45-degree field of view
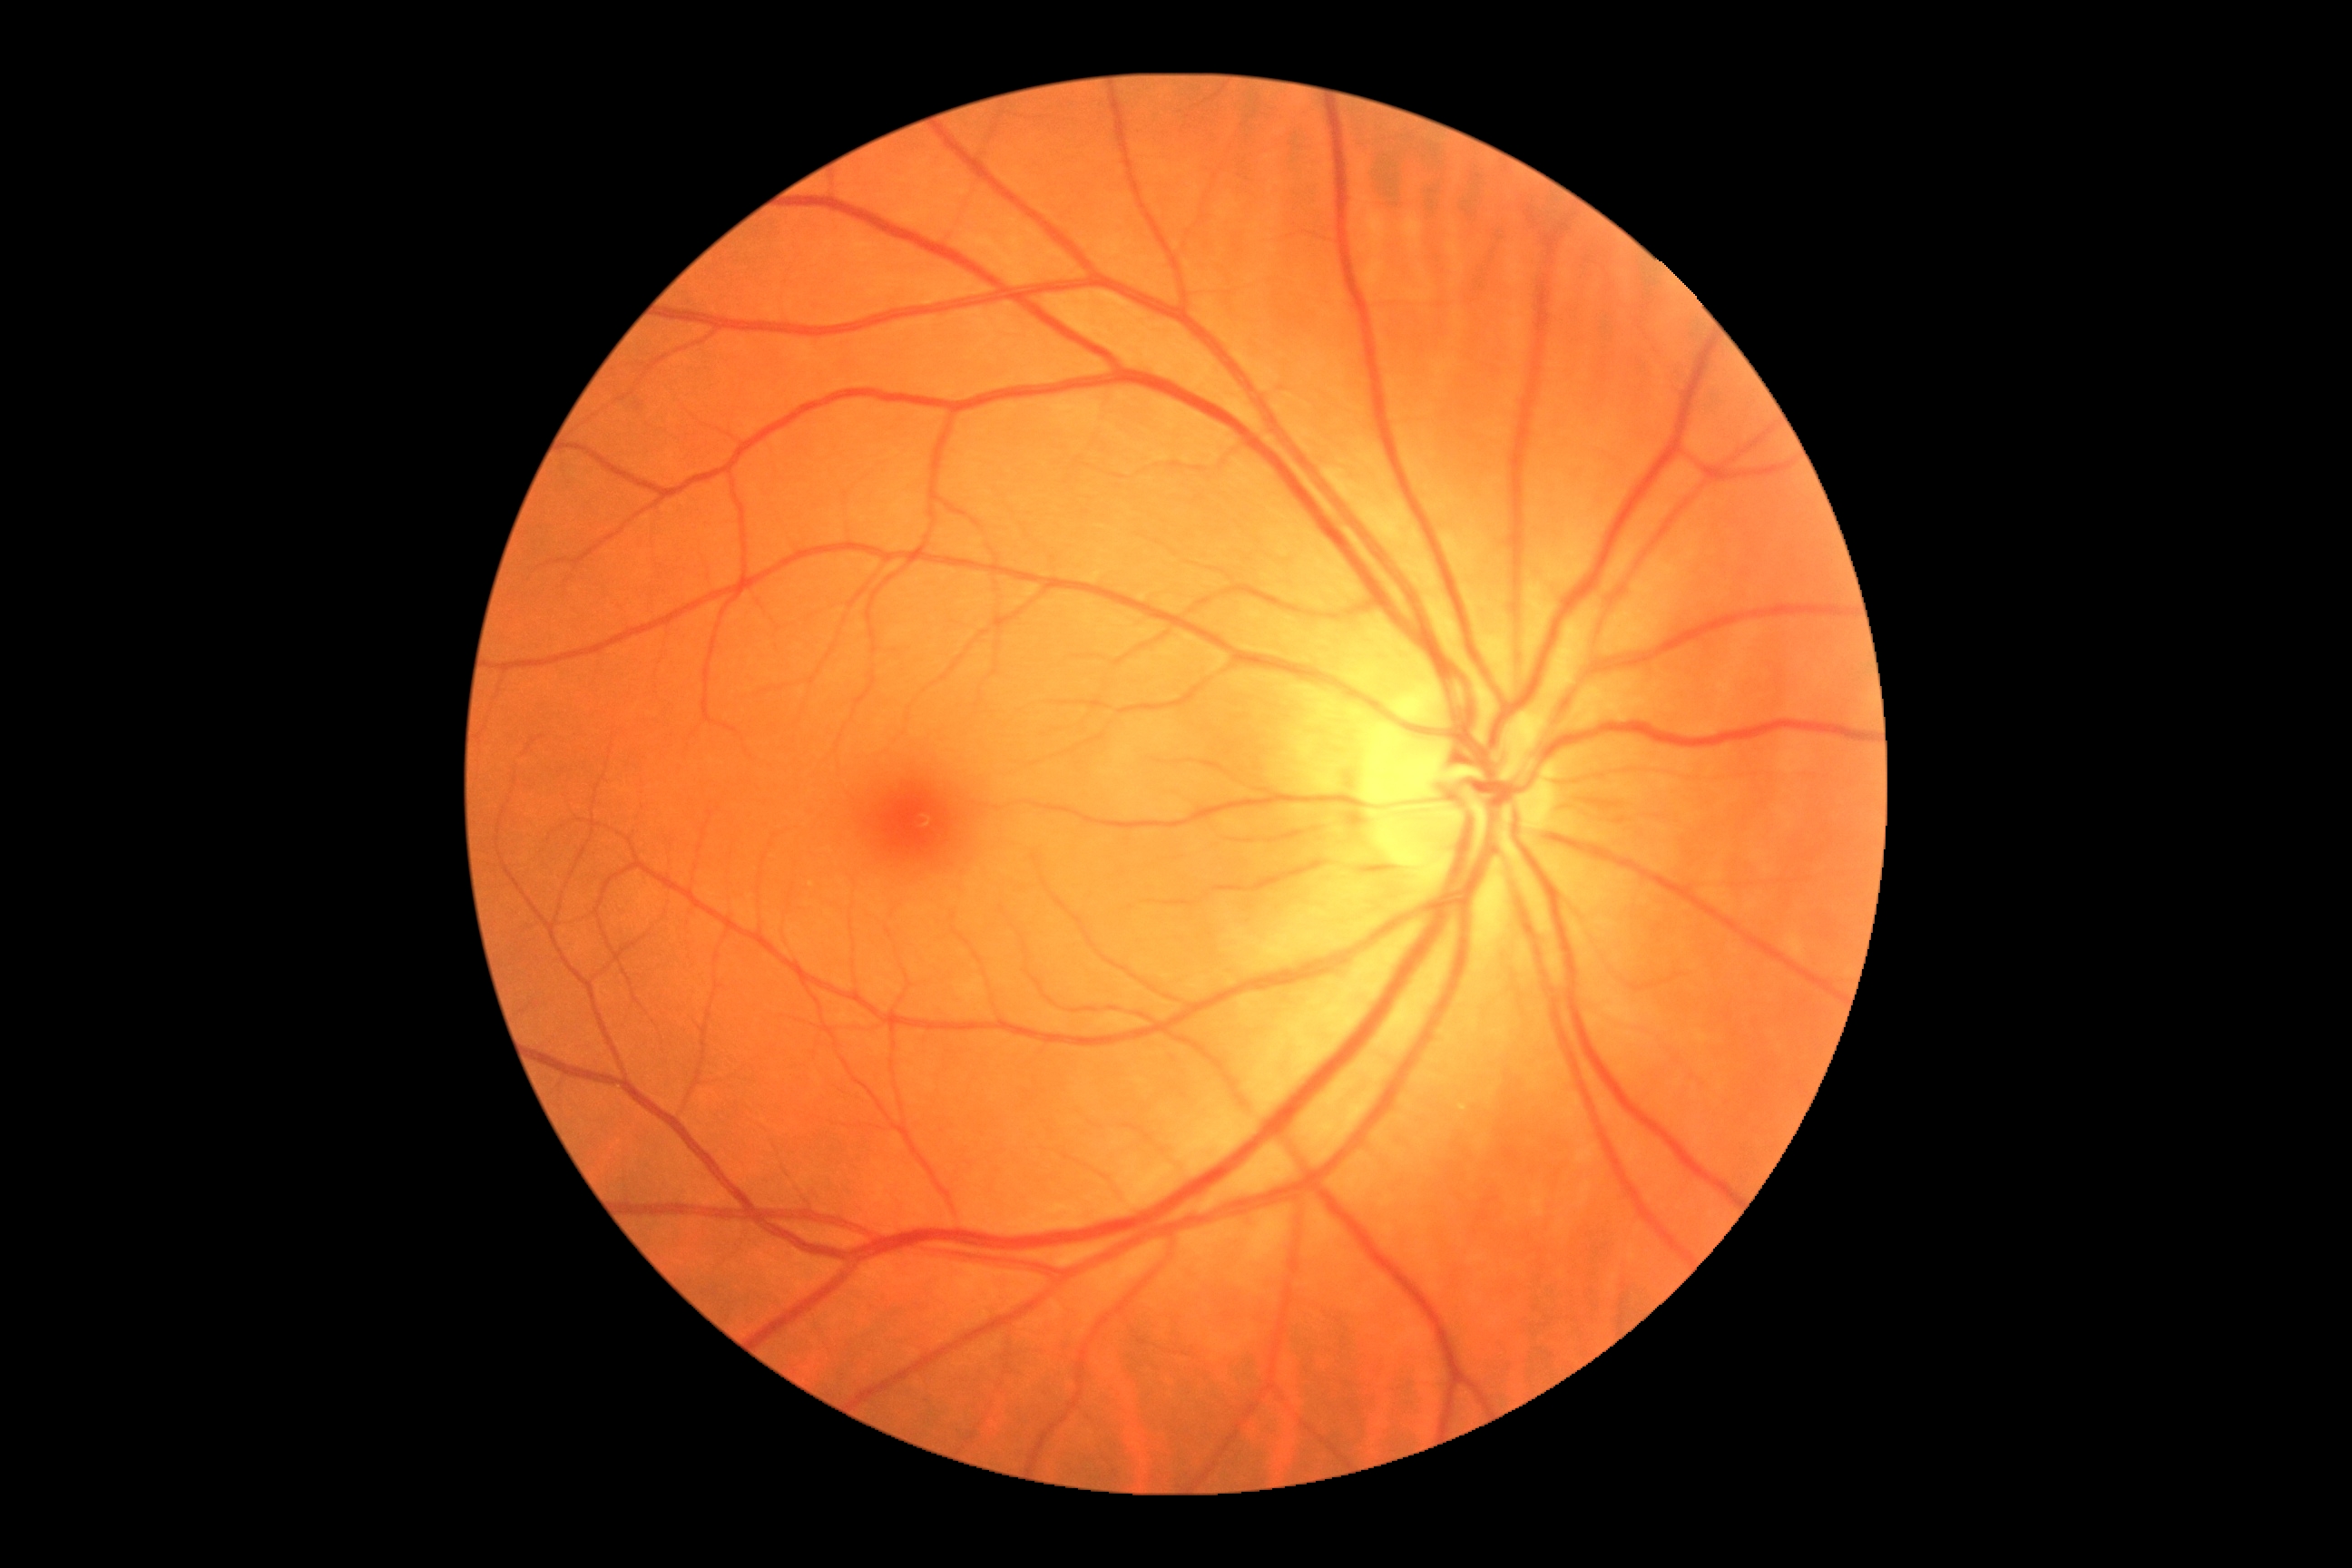
DR stage=no apparent retinopathy (grade 0).